Camera: Phoenix ICON (100° FOV). Wide-field contact fundus photograph of an infant — 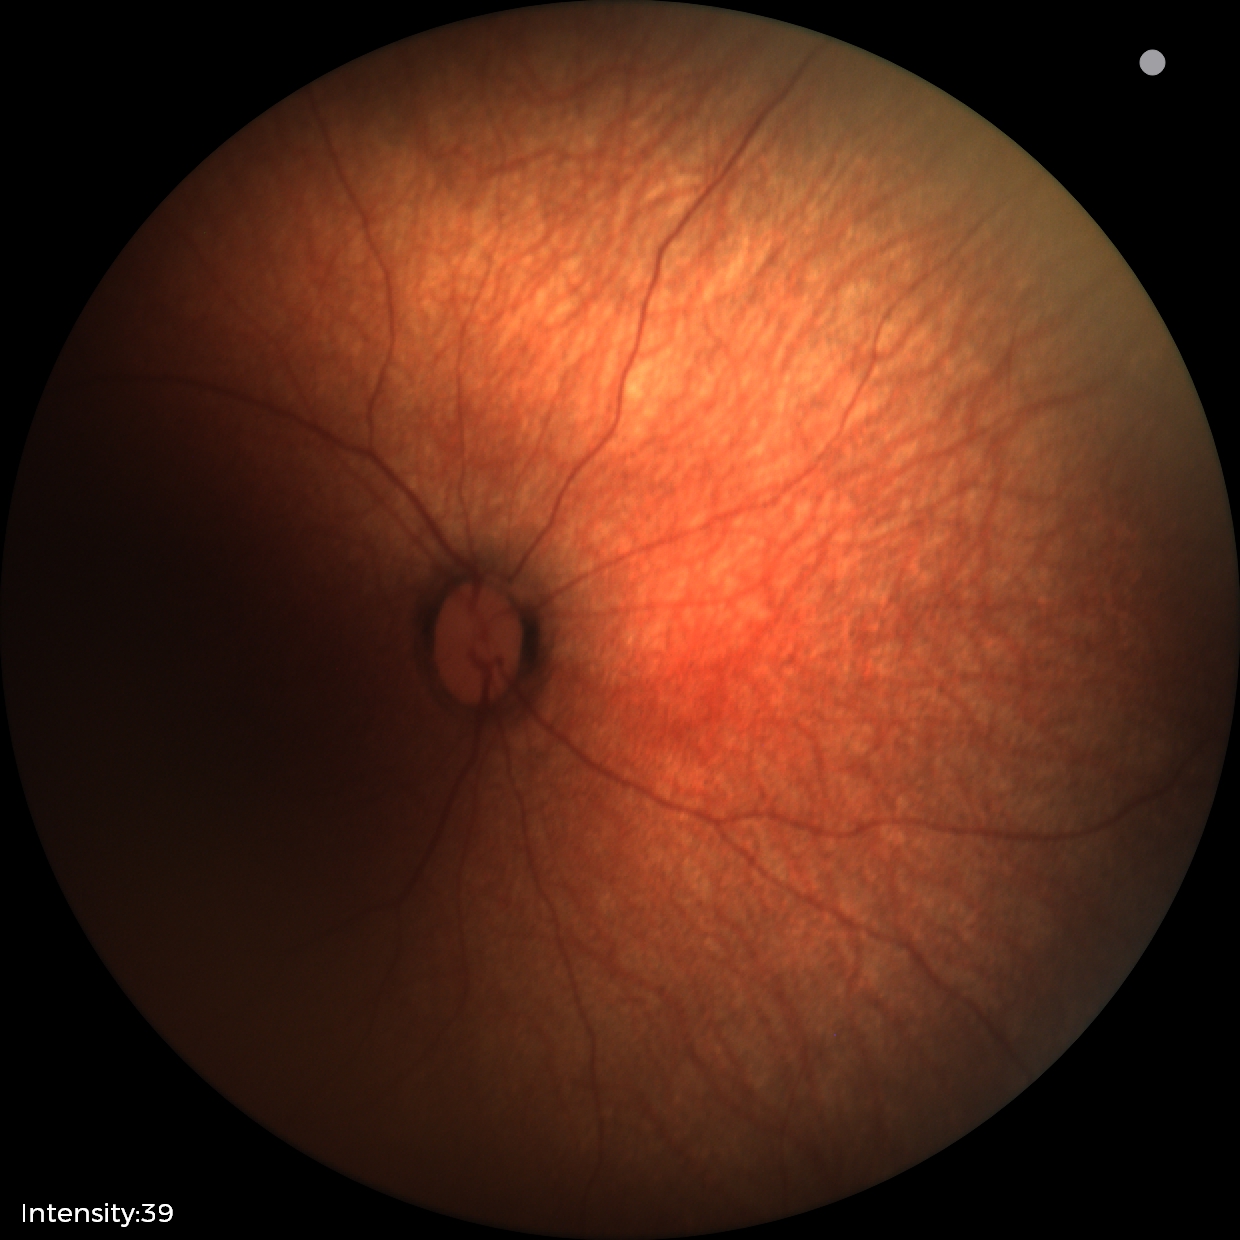
Normal screening examination.